Image size 2048x1536 · CFP: 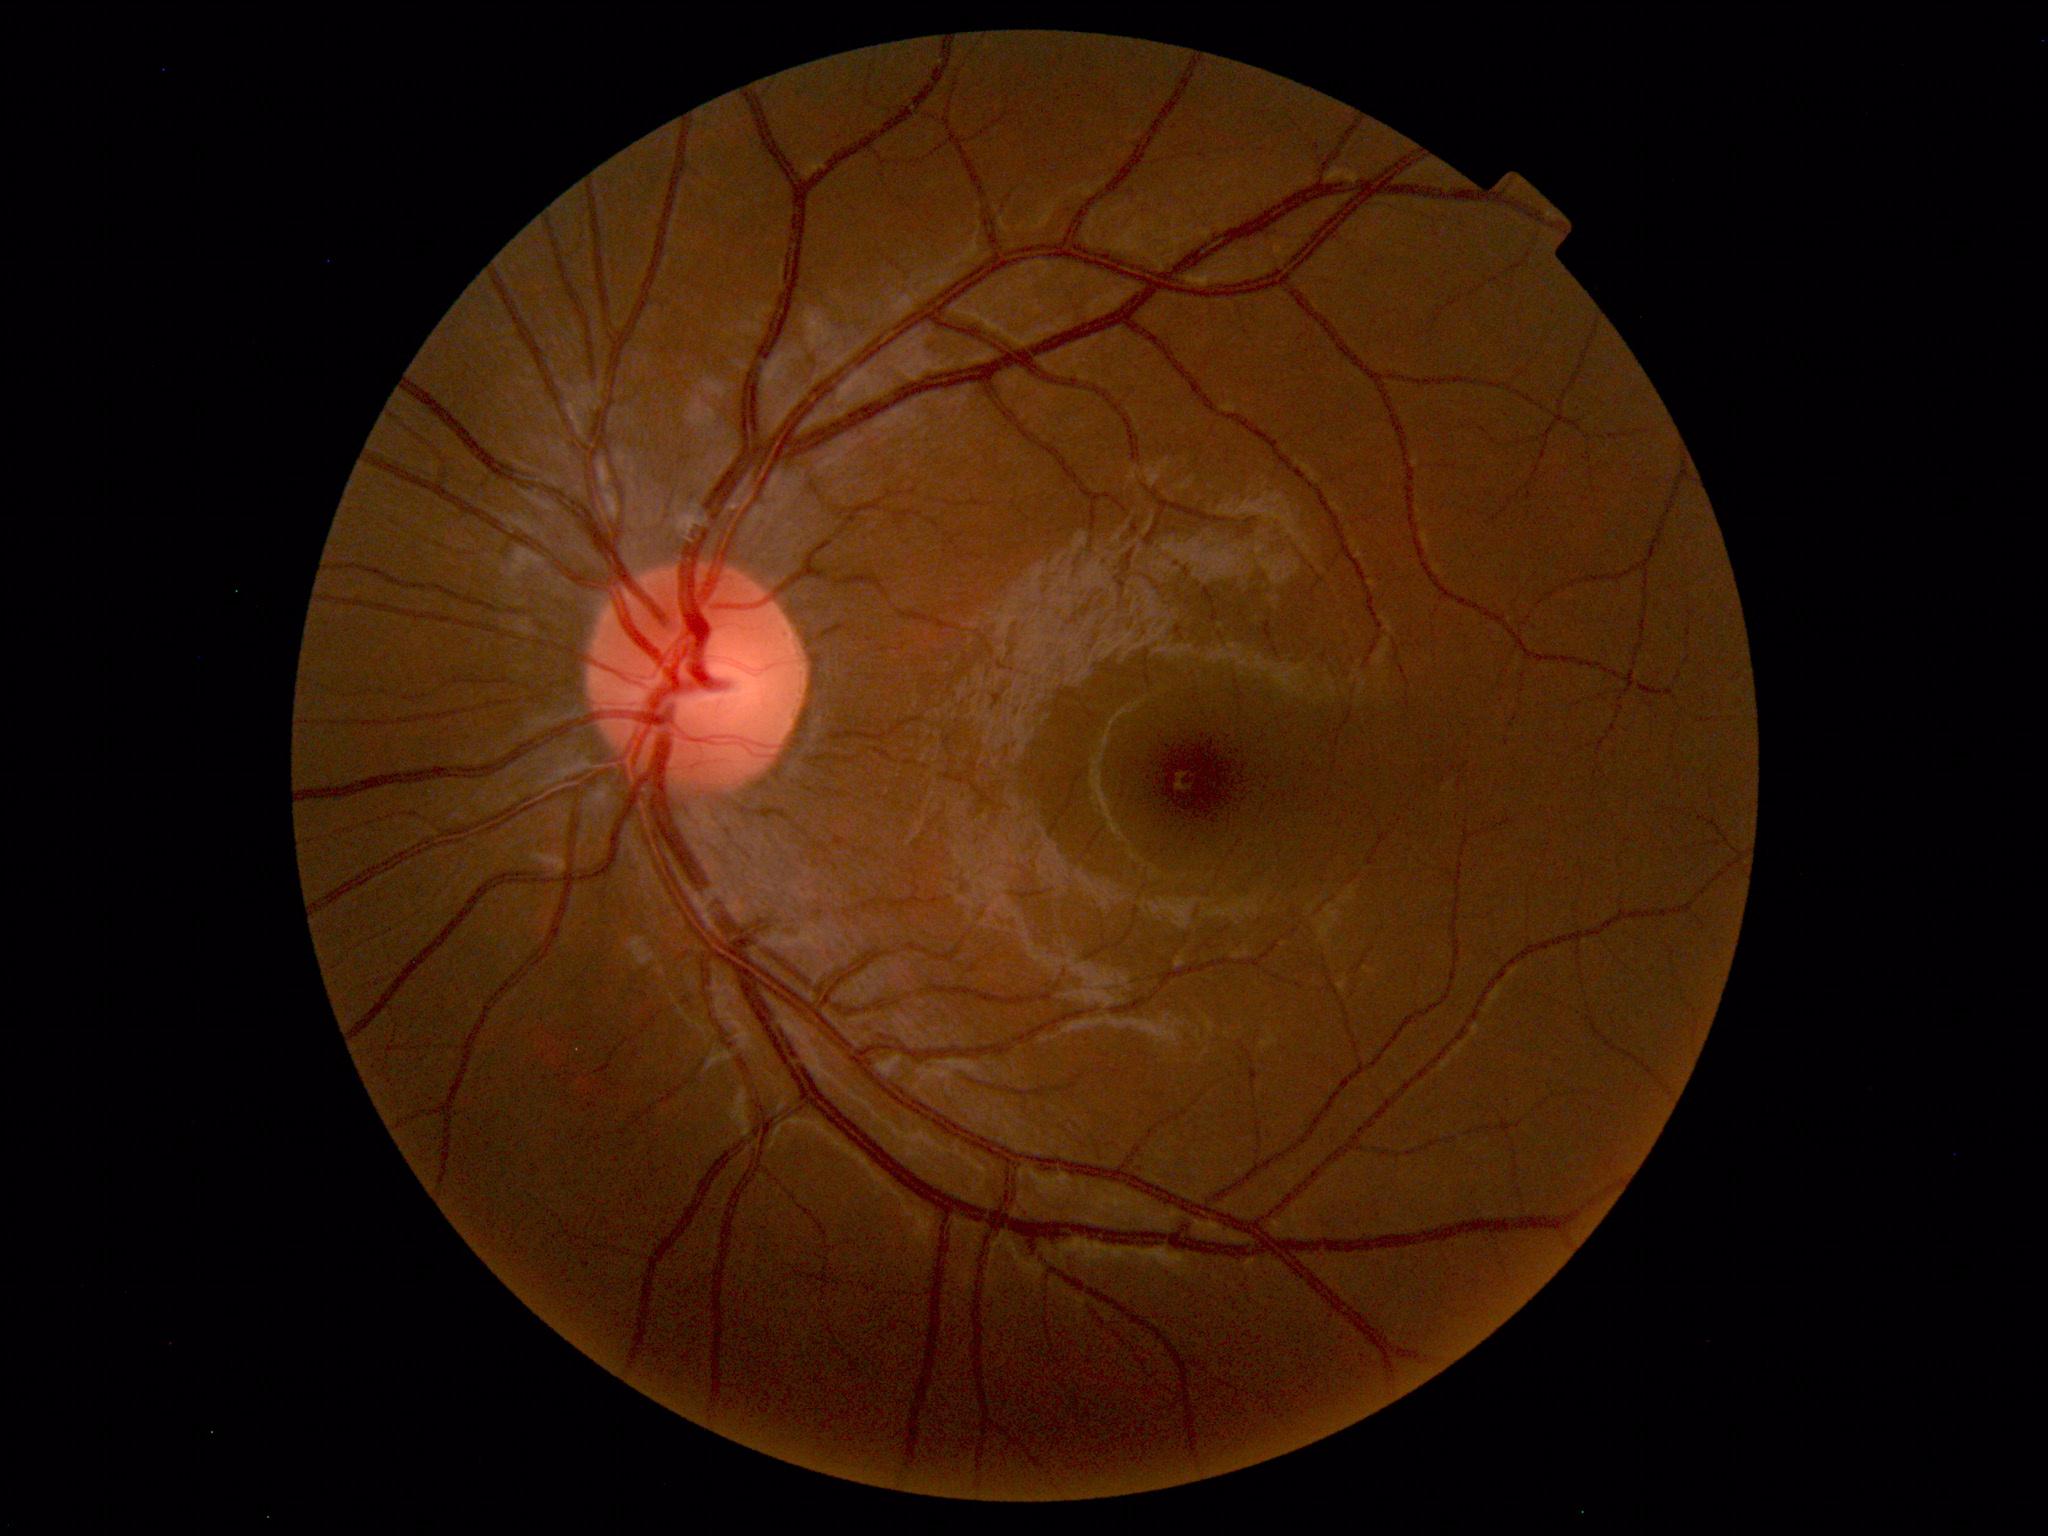 No abnormal findings on fundus examination.